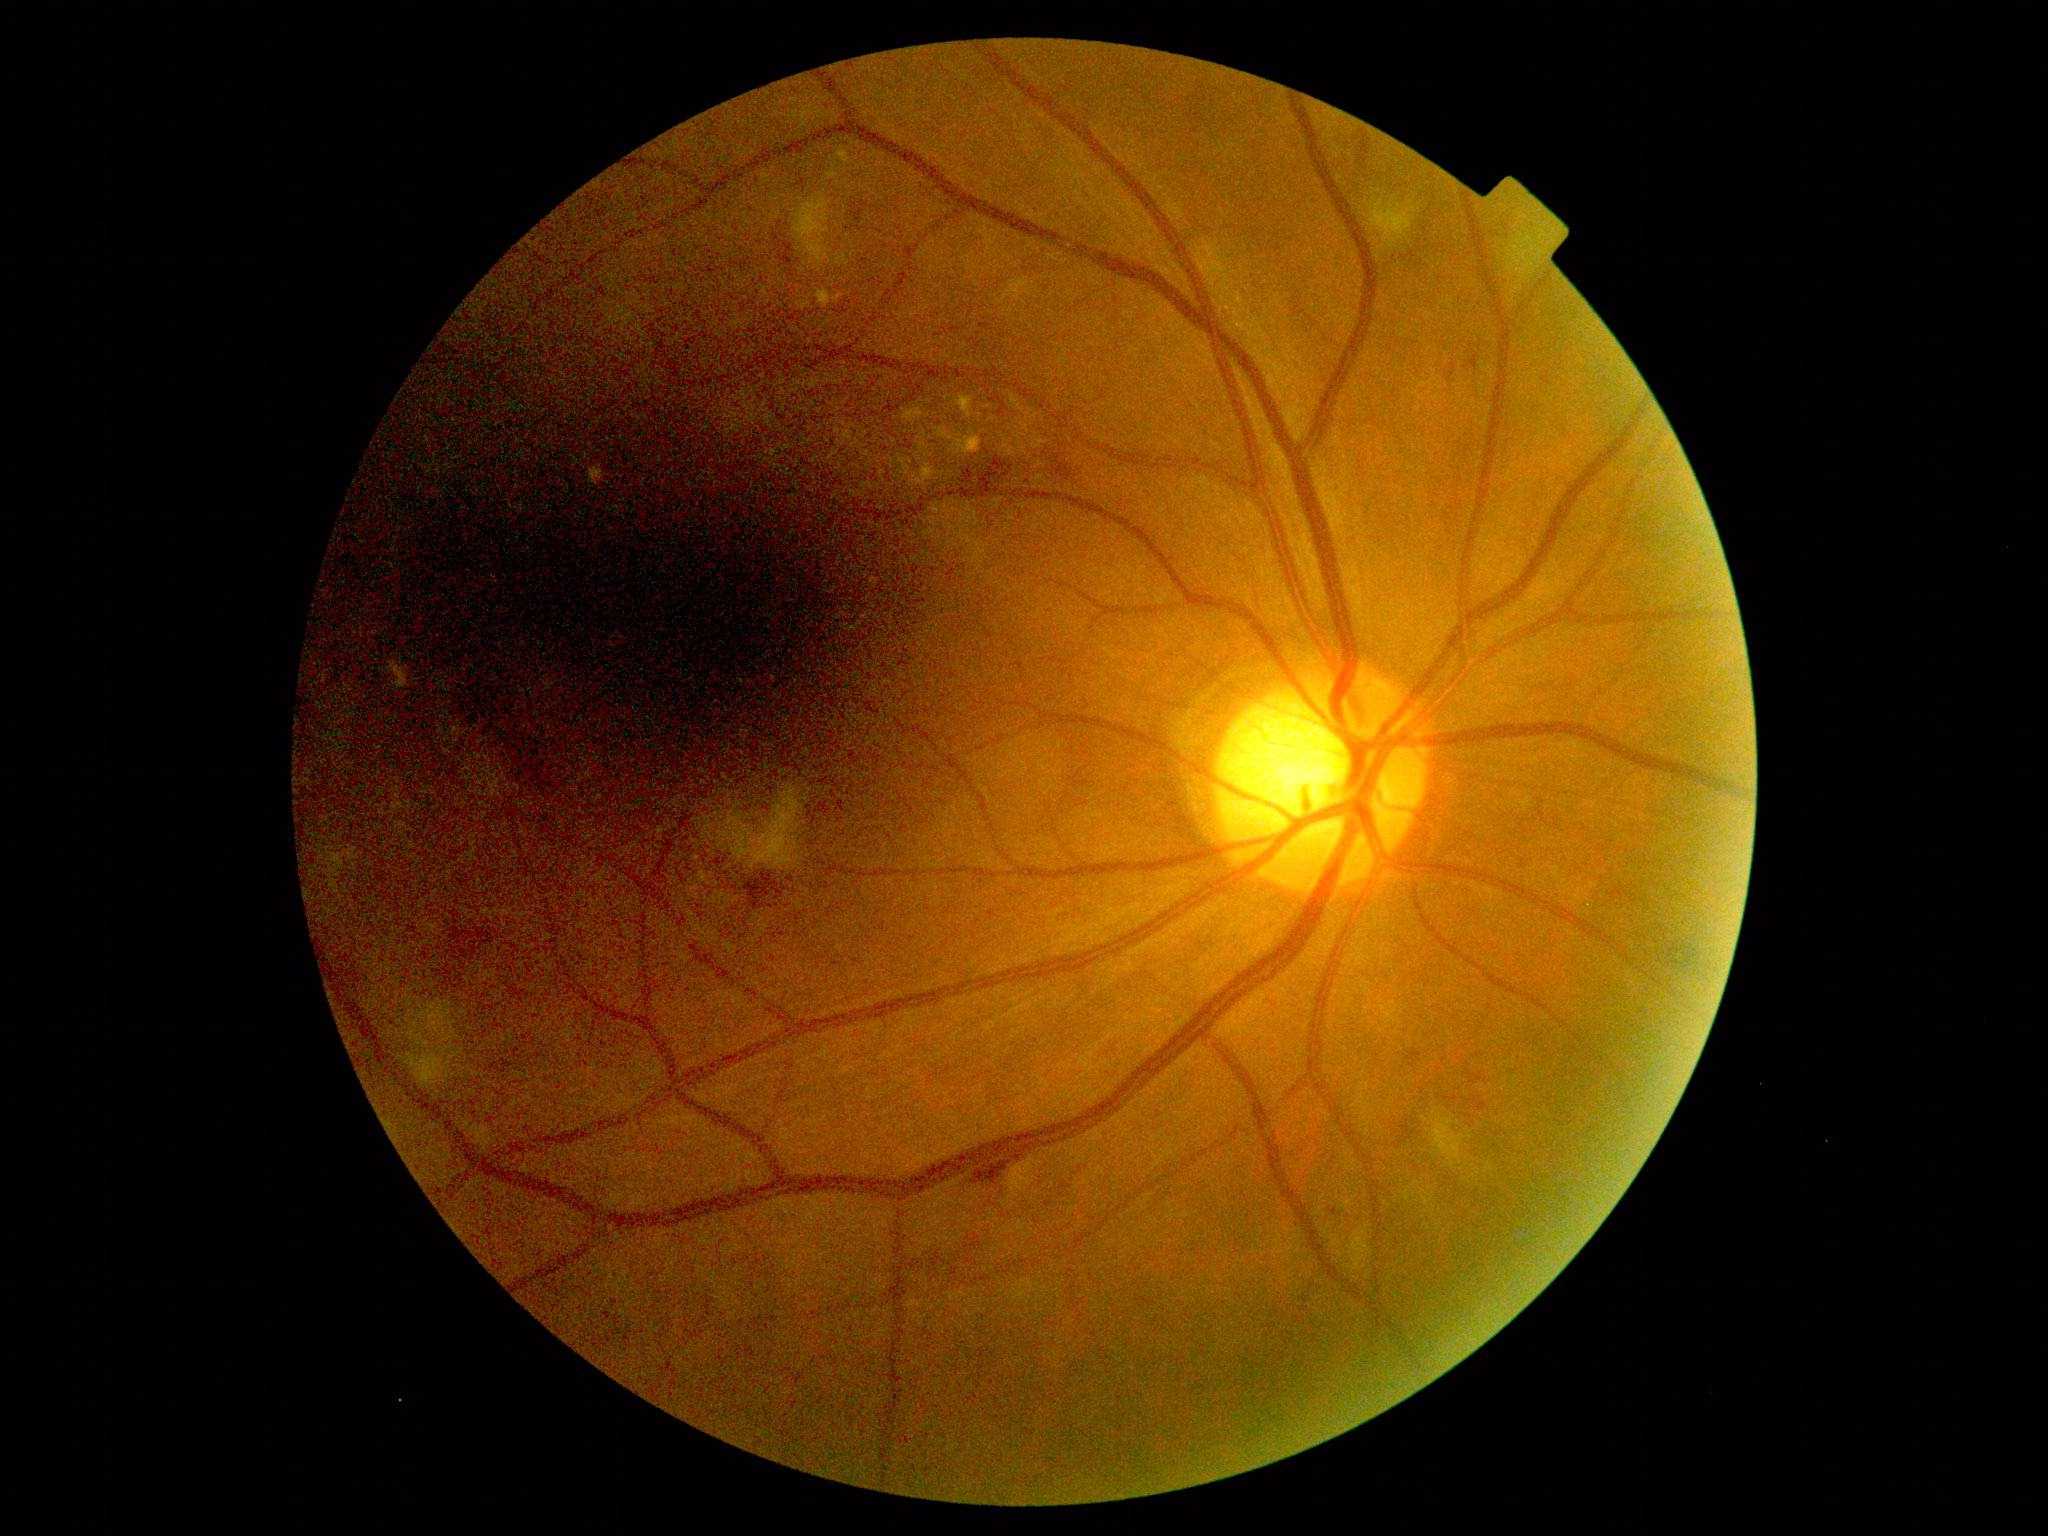 DR severity = 2/4.